Captured with the Clarity RetCam 3 (130° field of view); wide-field contact fundus photograph of an infant.
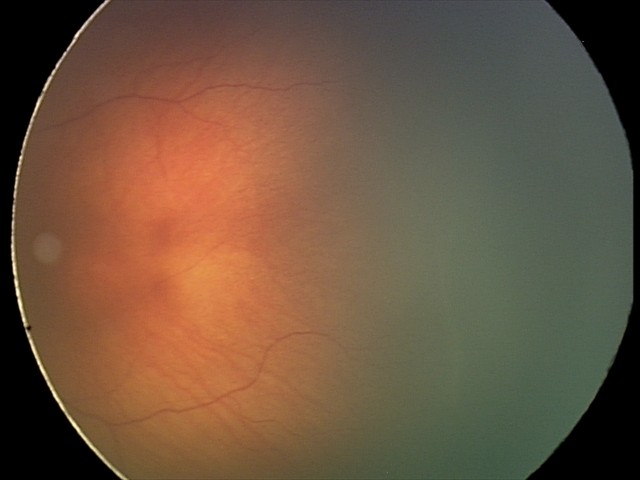
Without plus disease. Screening examination consistent with retinopathy of prematurity (ROP) stage 2.